Color fundus image; 45° FOV:
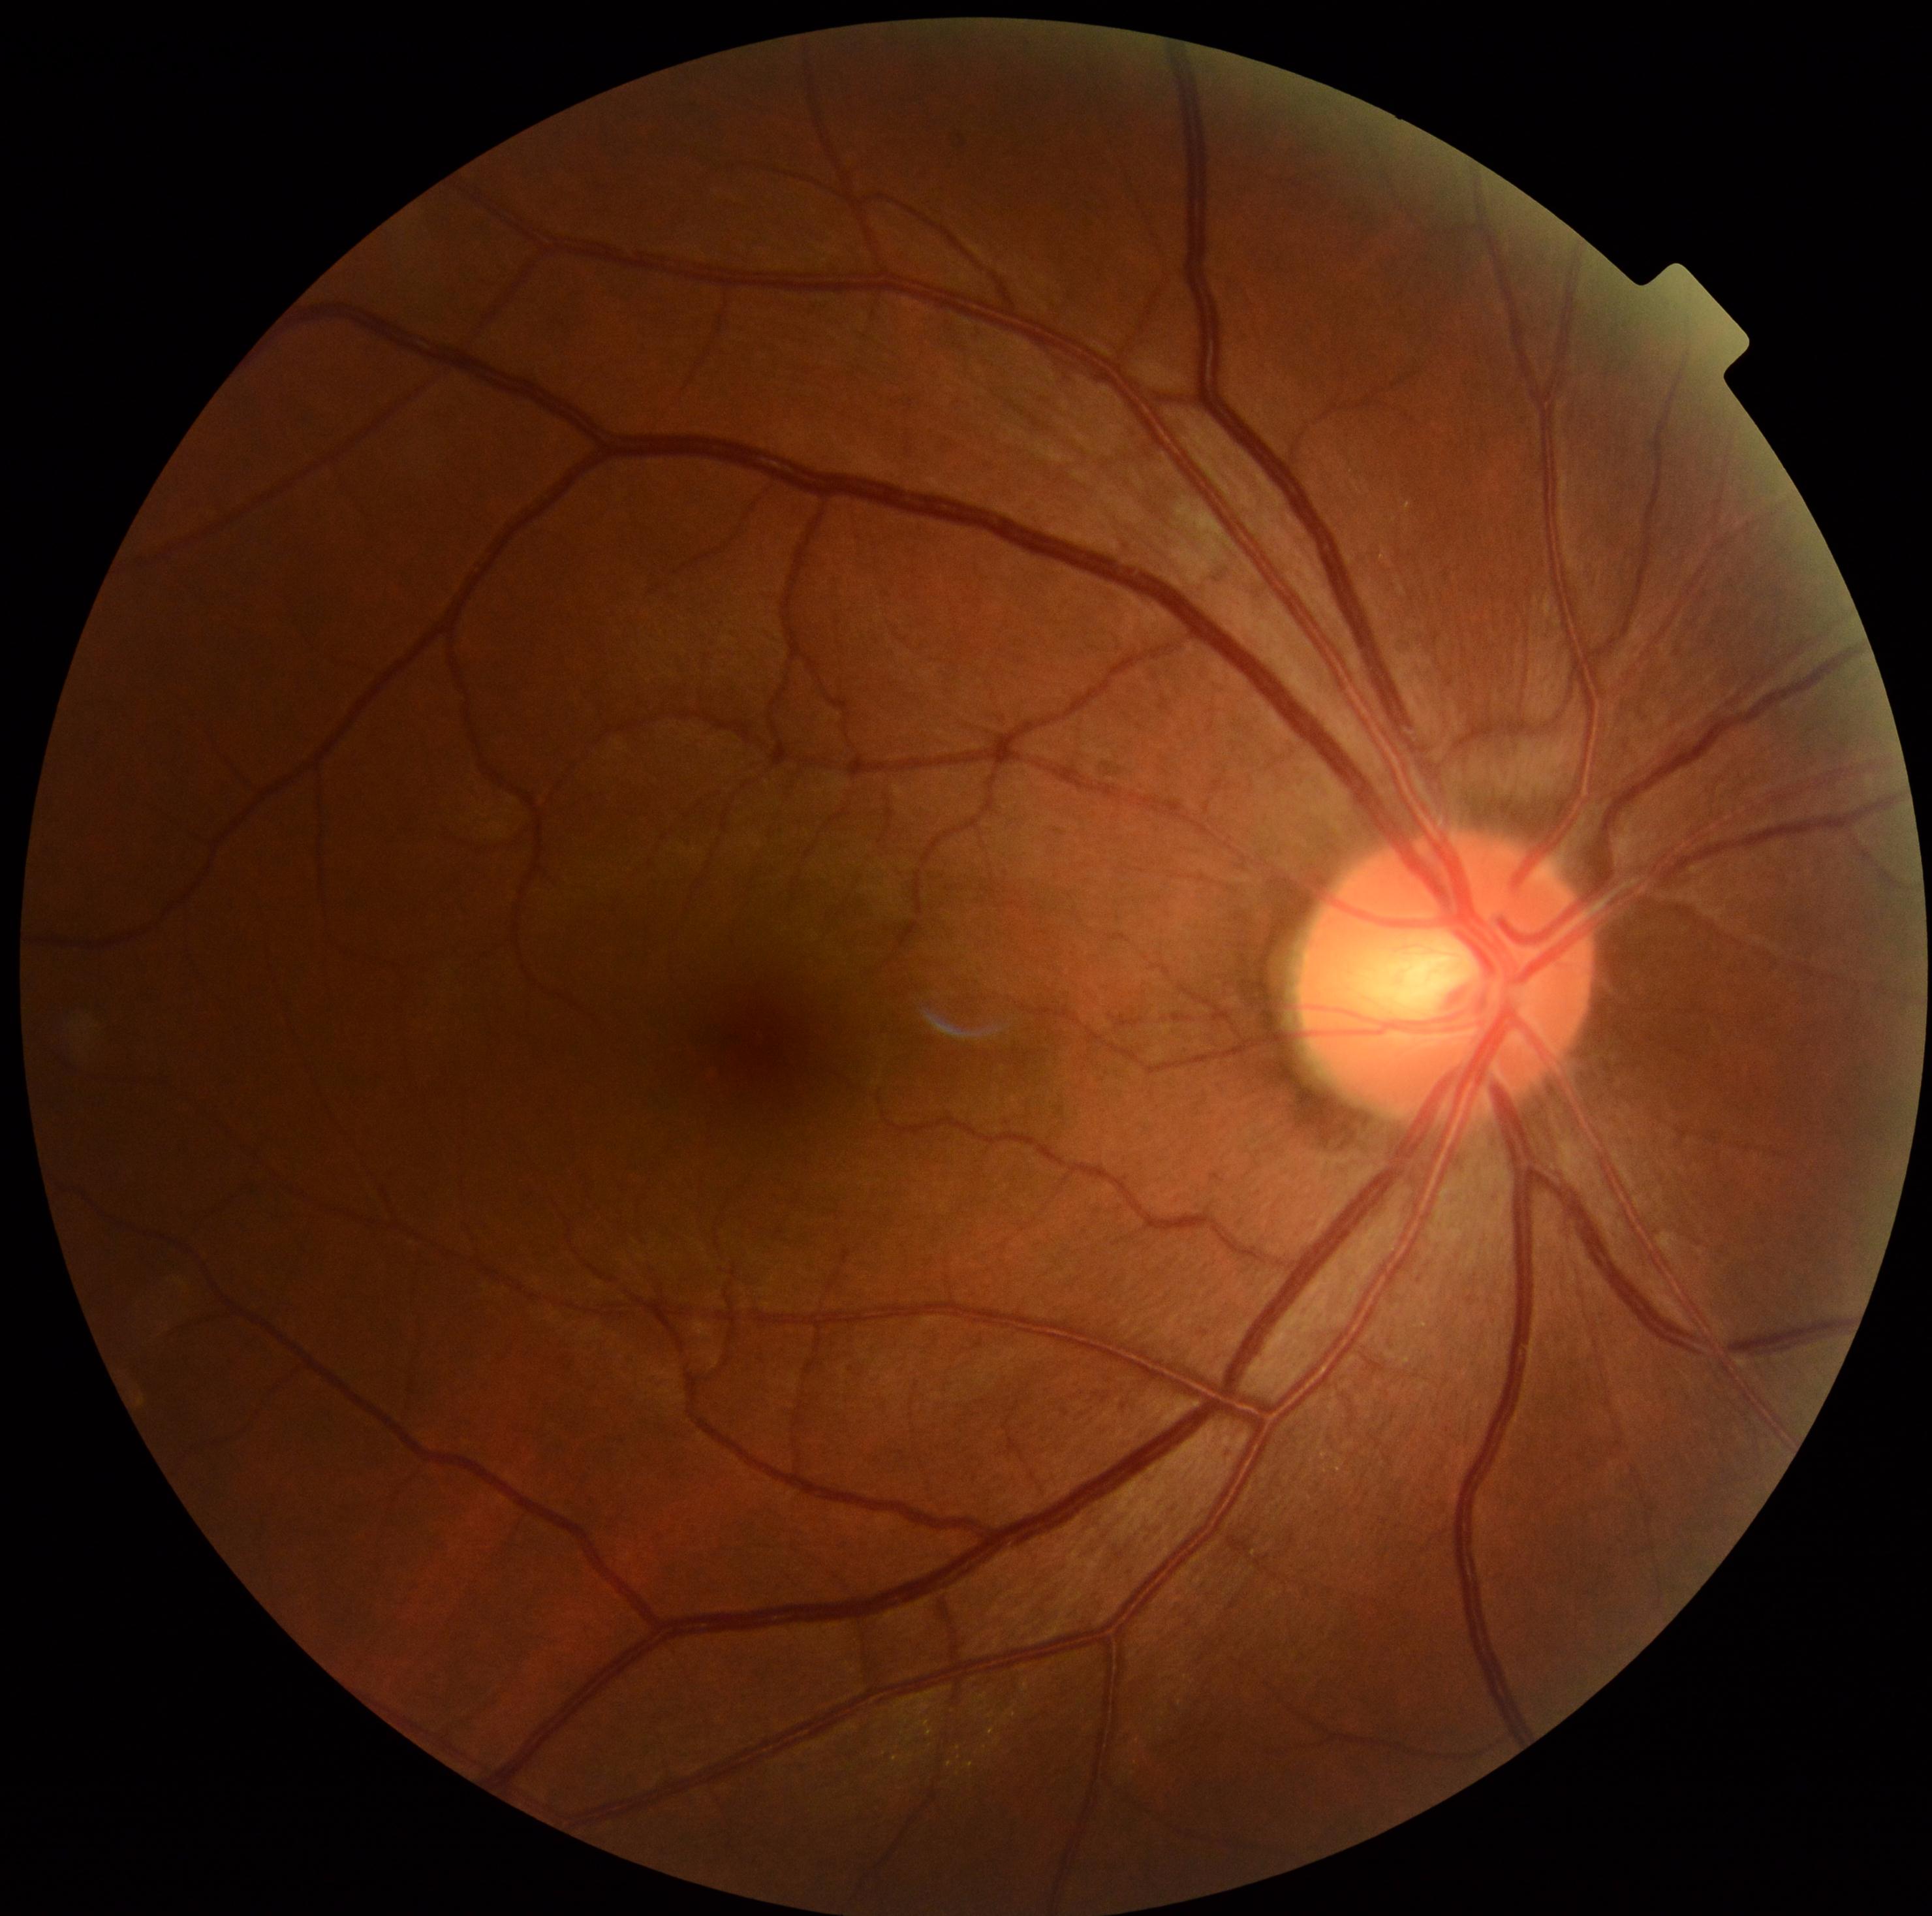

DR stage: grade 2 (moderate NPDR).